Captured without pupil dilation · 240 x 240 pixels · acquired with a Nidek AFC-330
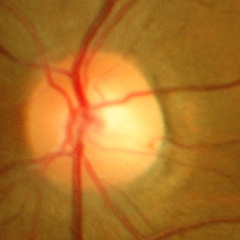

Glaucoma assessment: no signs of glaucoma.